Wide-field fundus photograph of an infant · captured with the Clarity RetCam 3 (130° field of view)
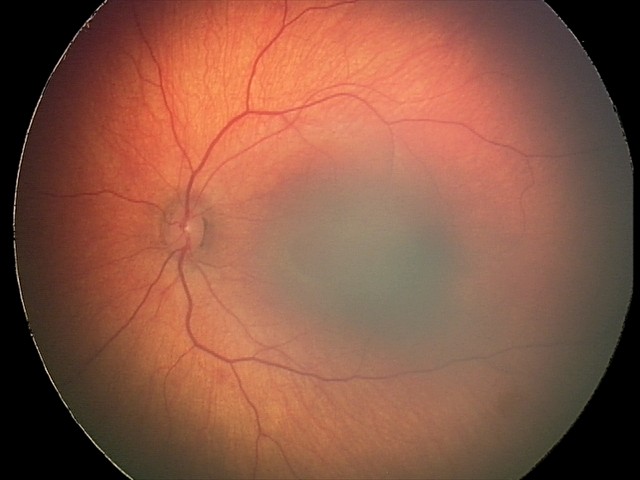 Screening series with retinal hemorrhages.